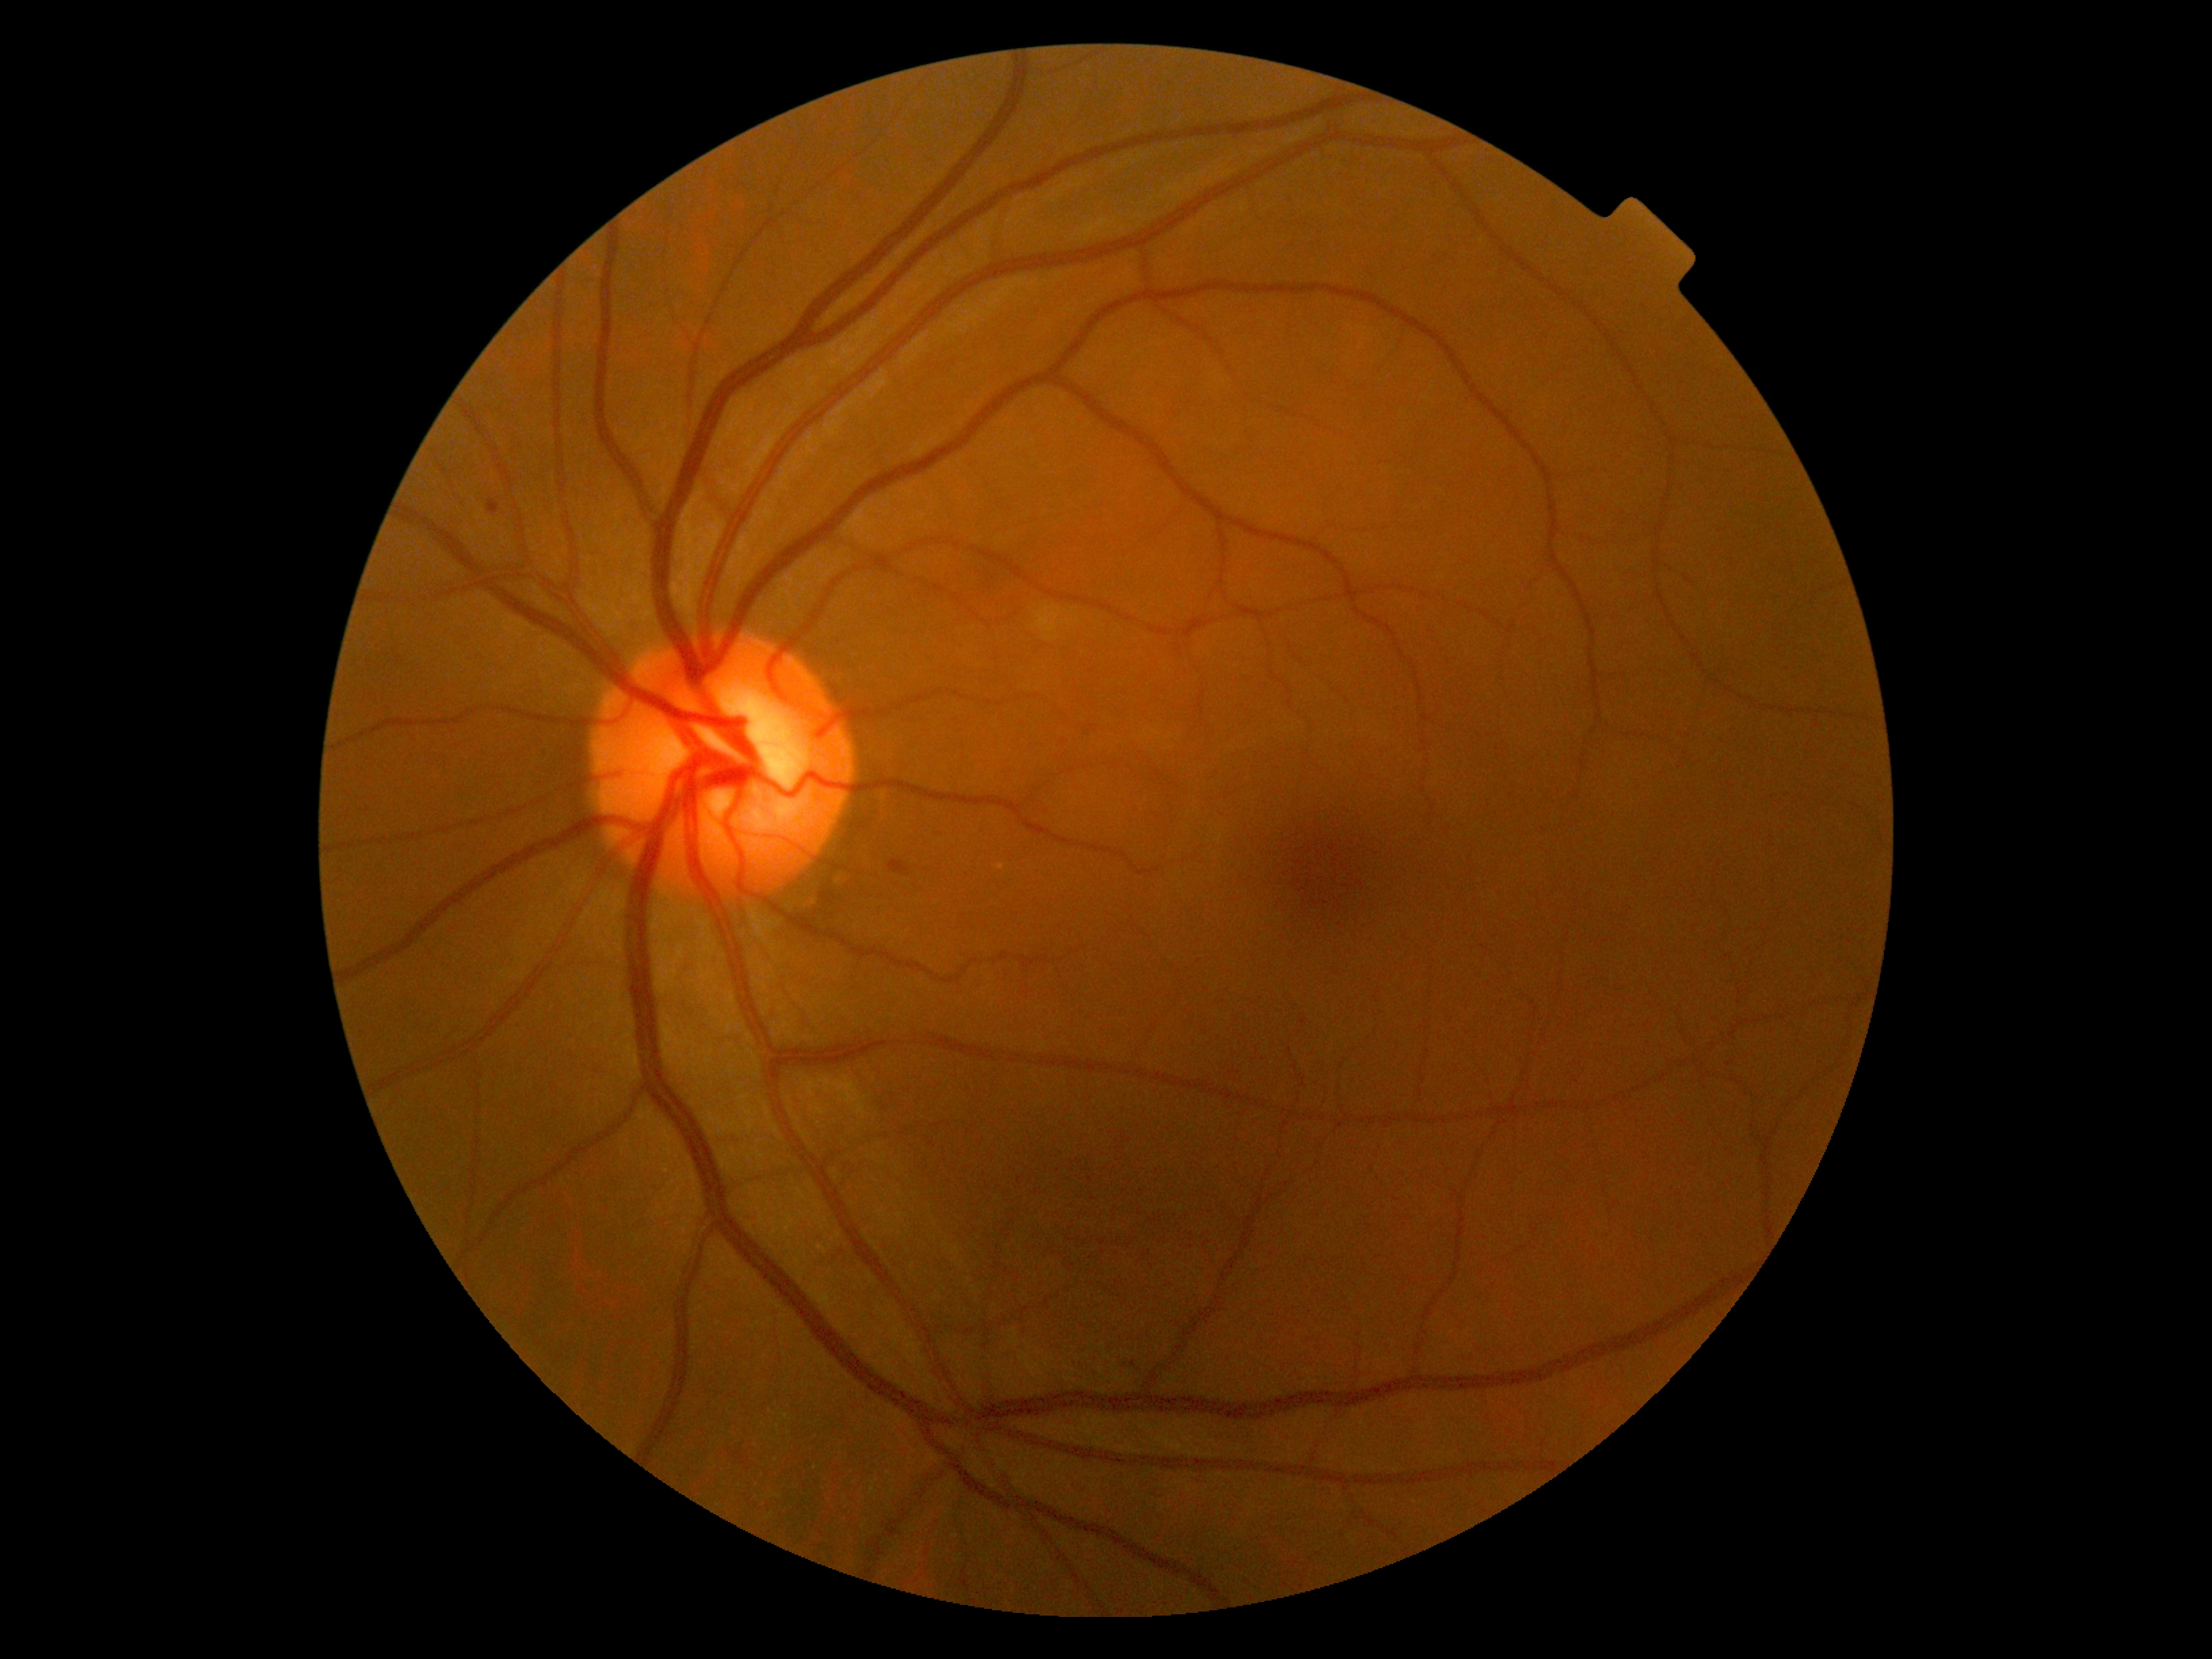

Diabetic retinopathy (DR): moderate NPDR (grade 2).
DR class: non-proliferative diabetic retinopathy.